Without pupil dilation · 45° FOV.
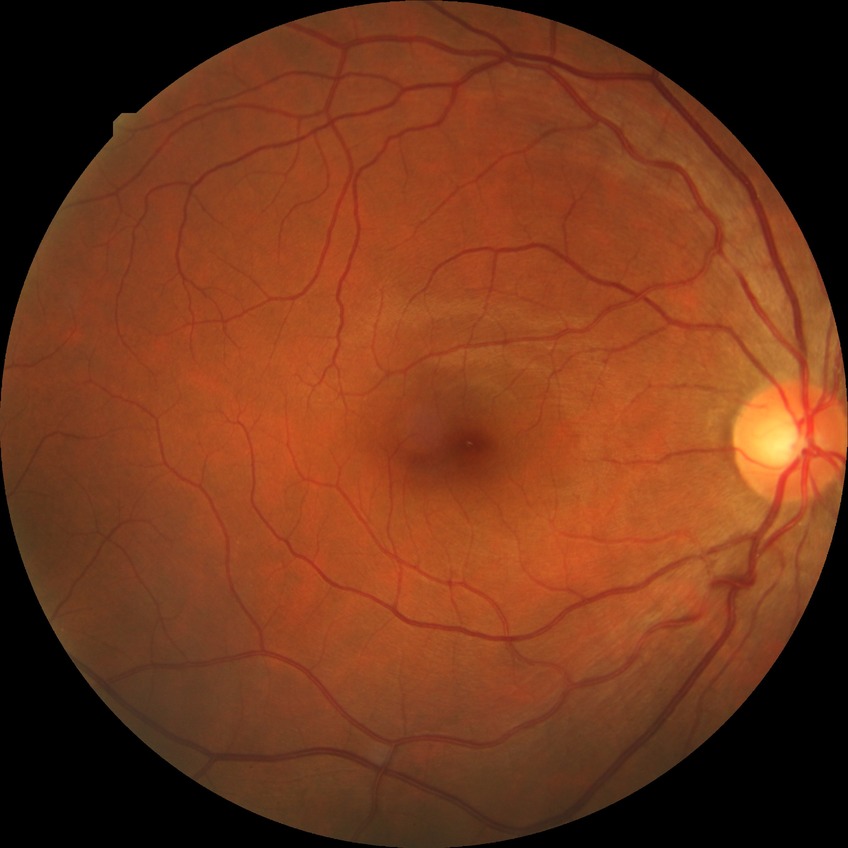
Diabetic retinopathy (DR): NDR (no diabetic retinopathy).